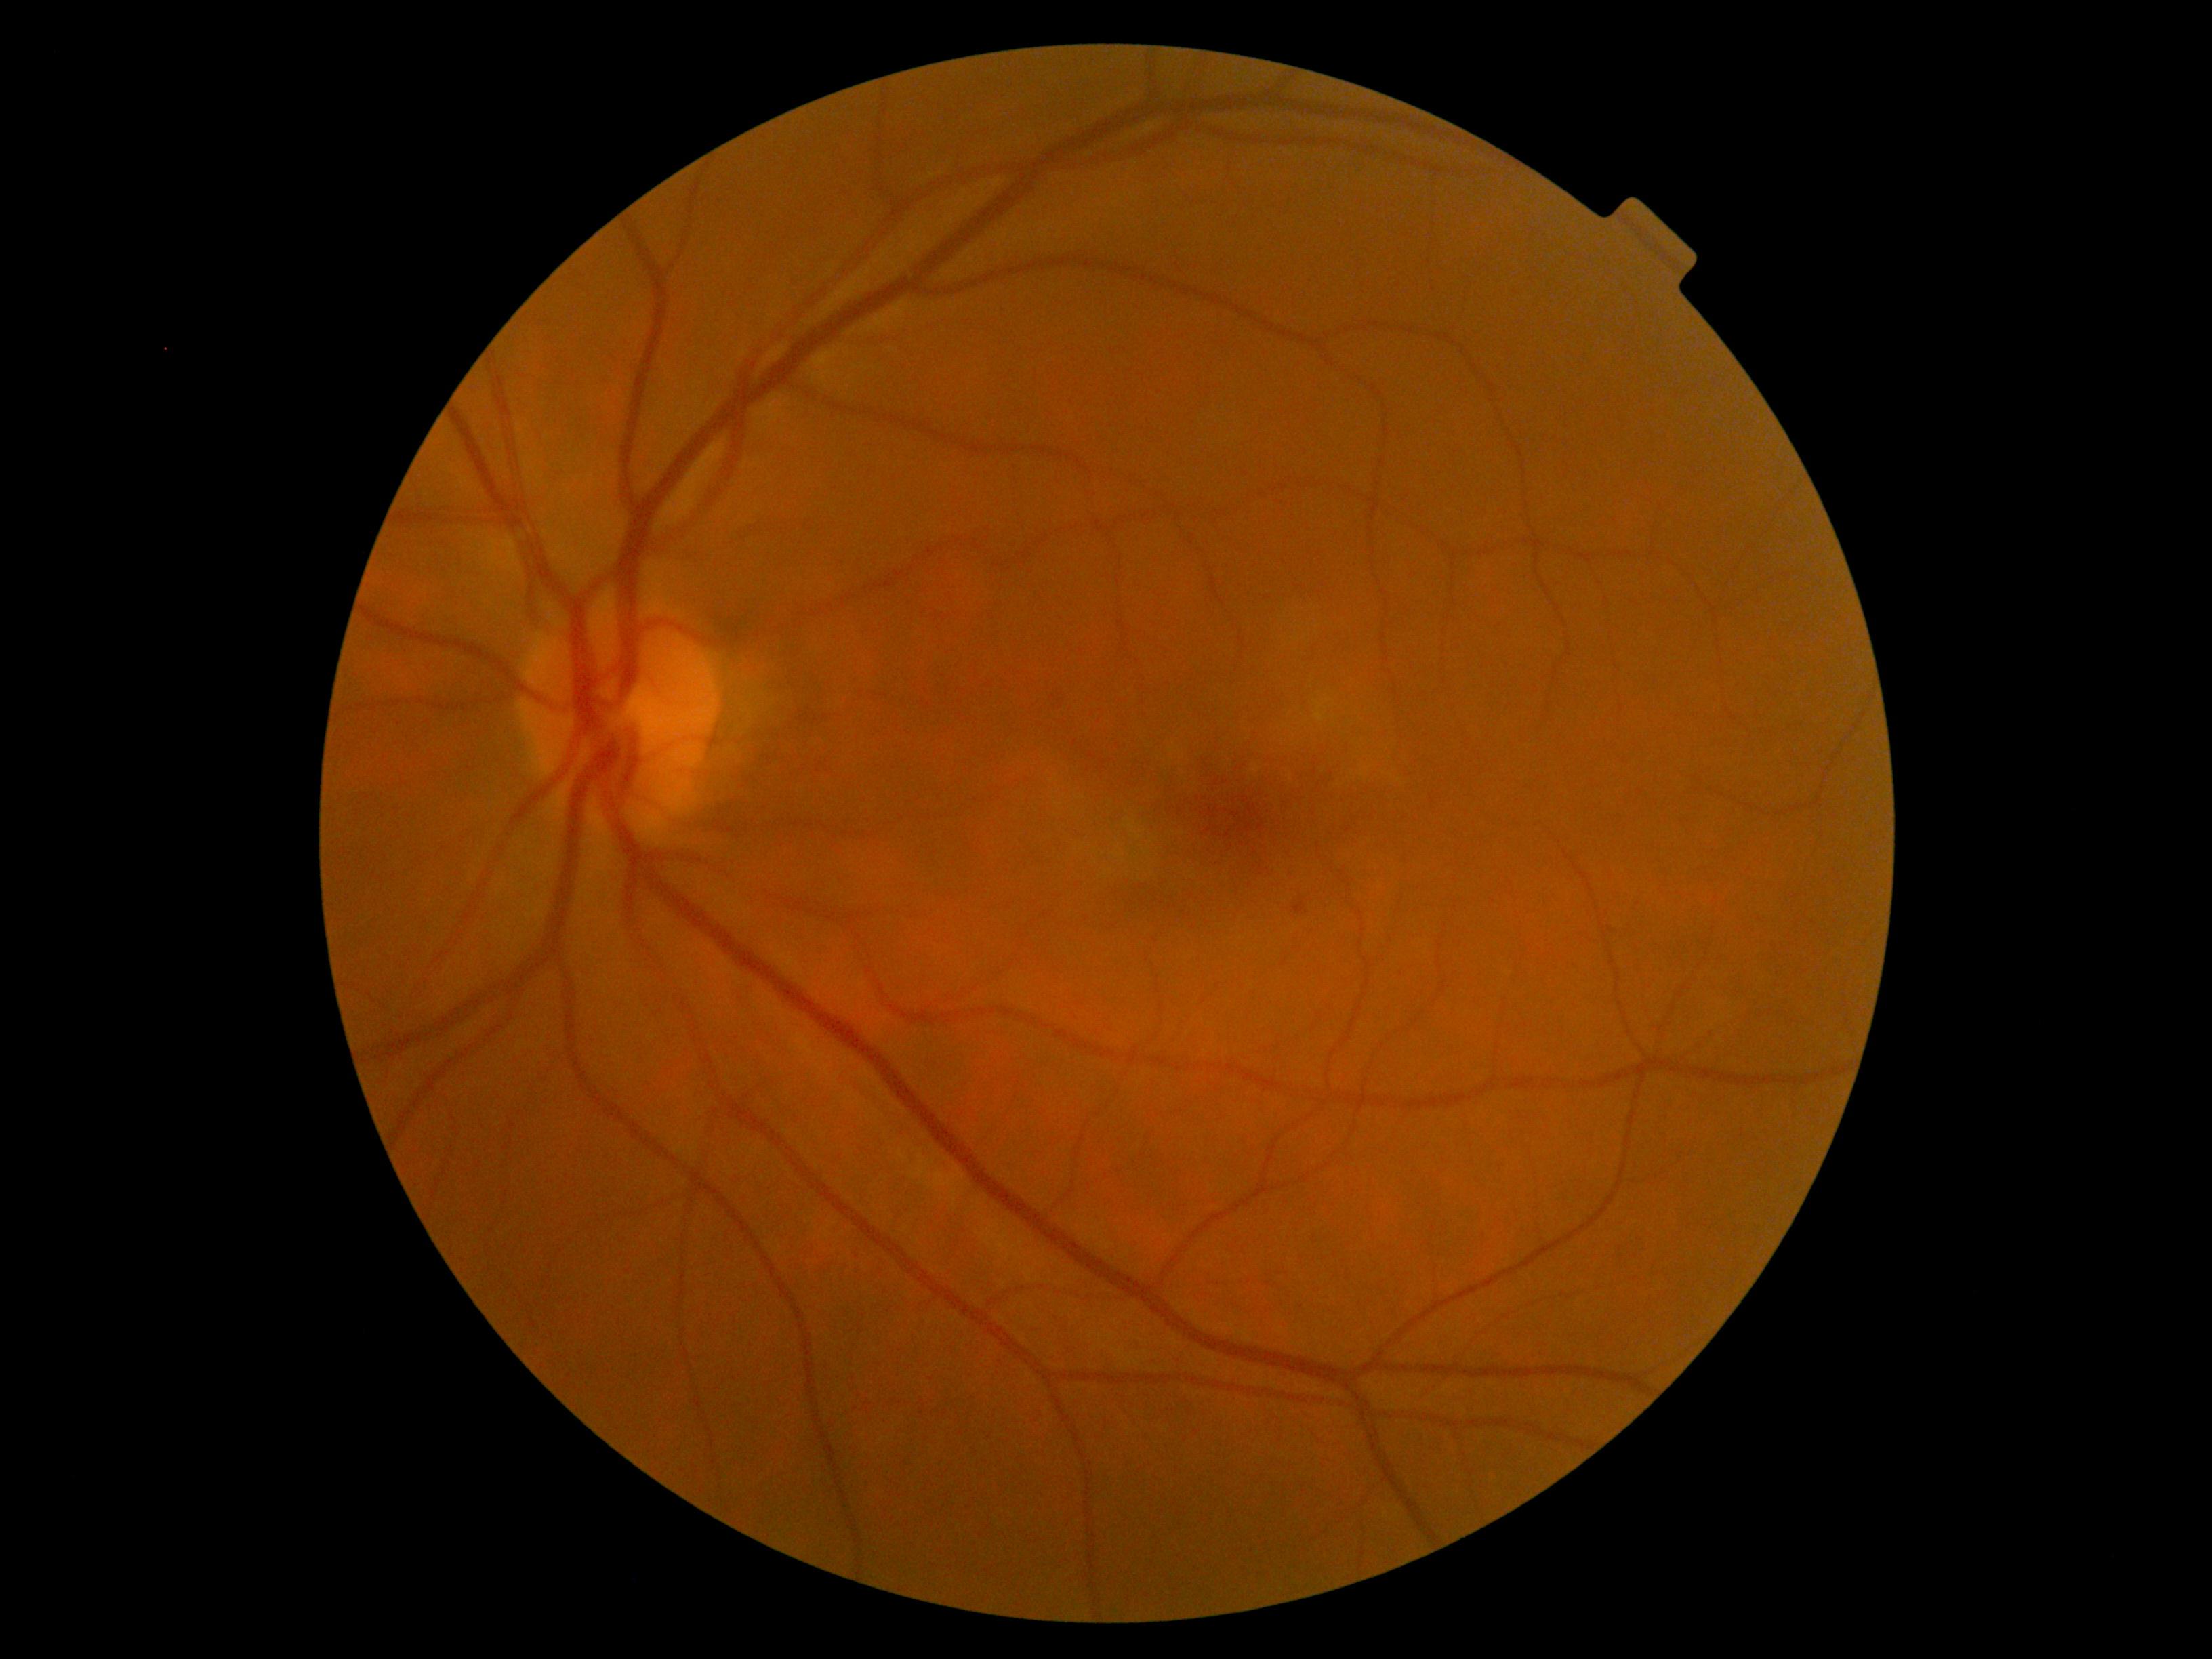

DR class: non-proliferative diabetic retinopathy.
Diabetic retinopathy (DR) is 1.